Retinal fundus photograph; 2184x1690px — 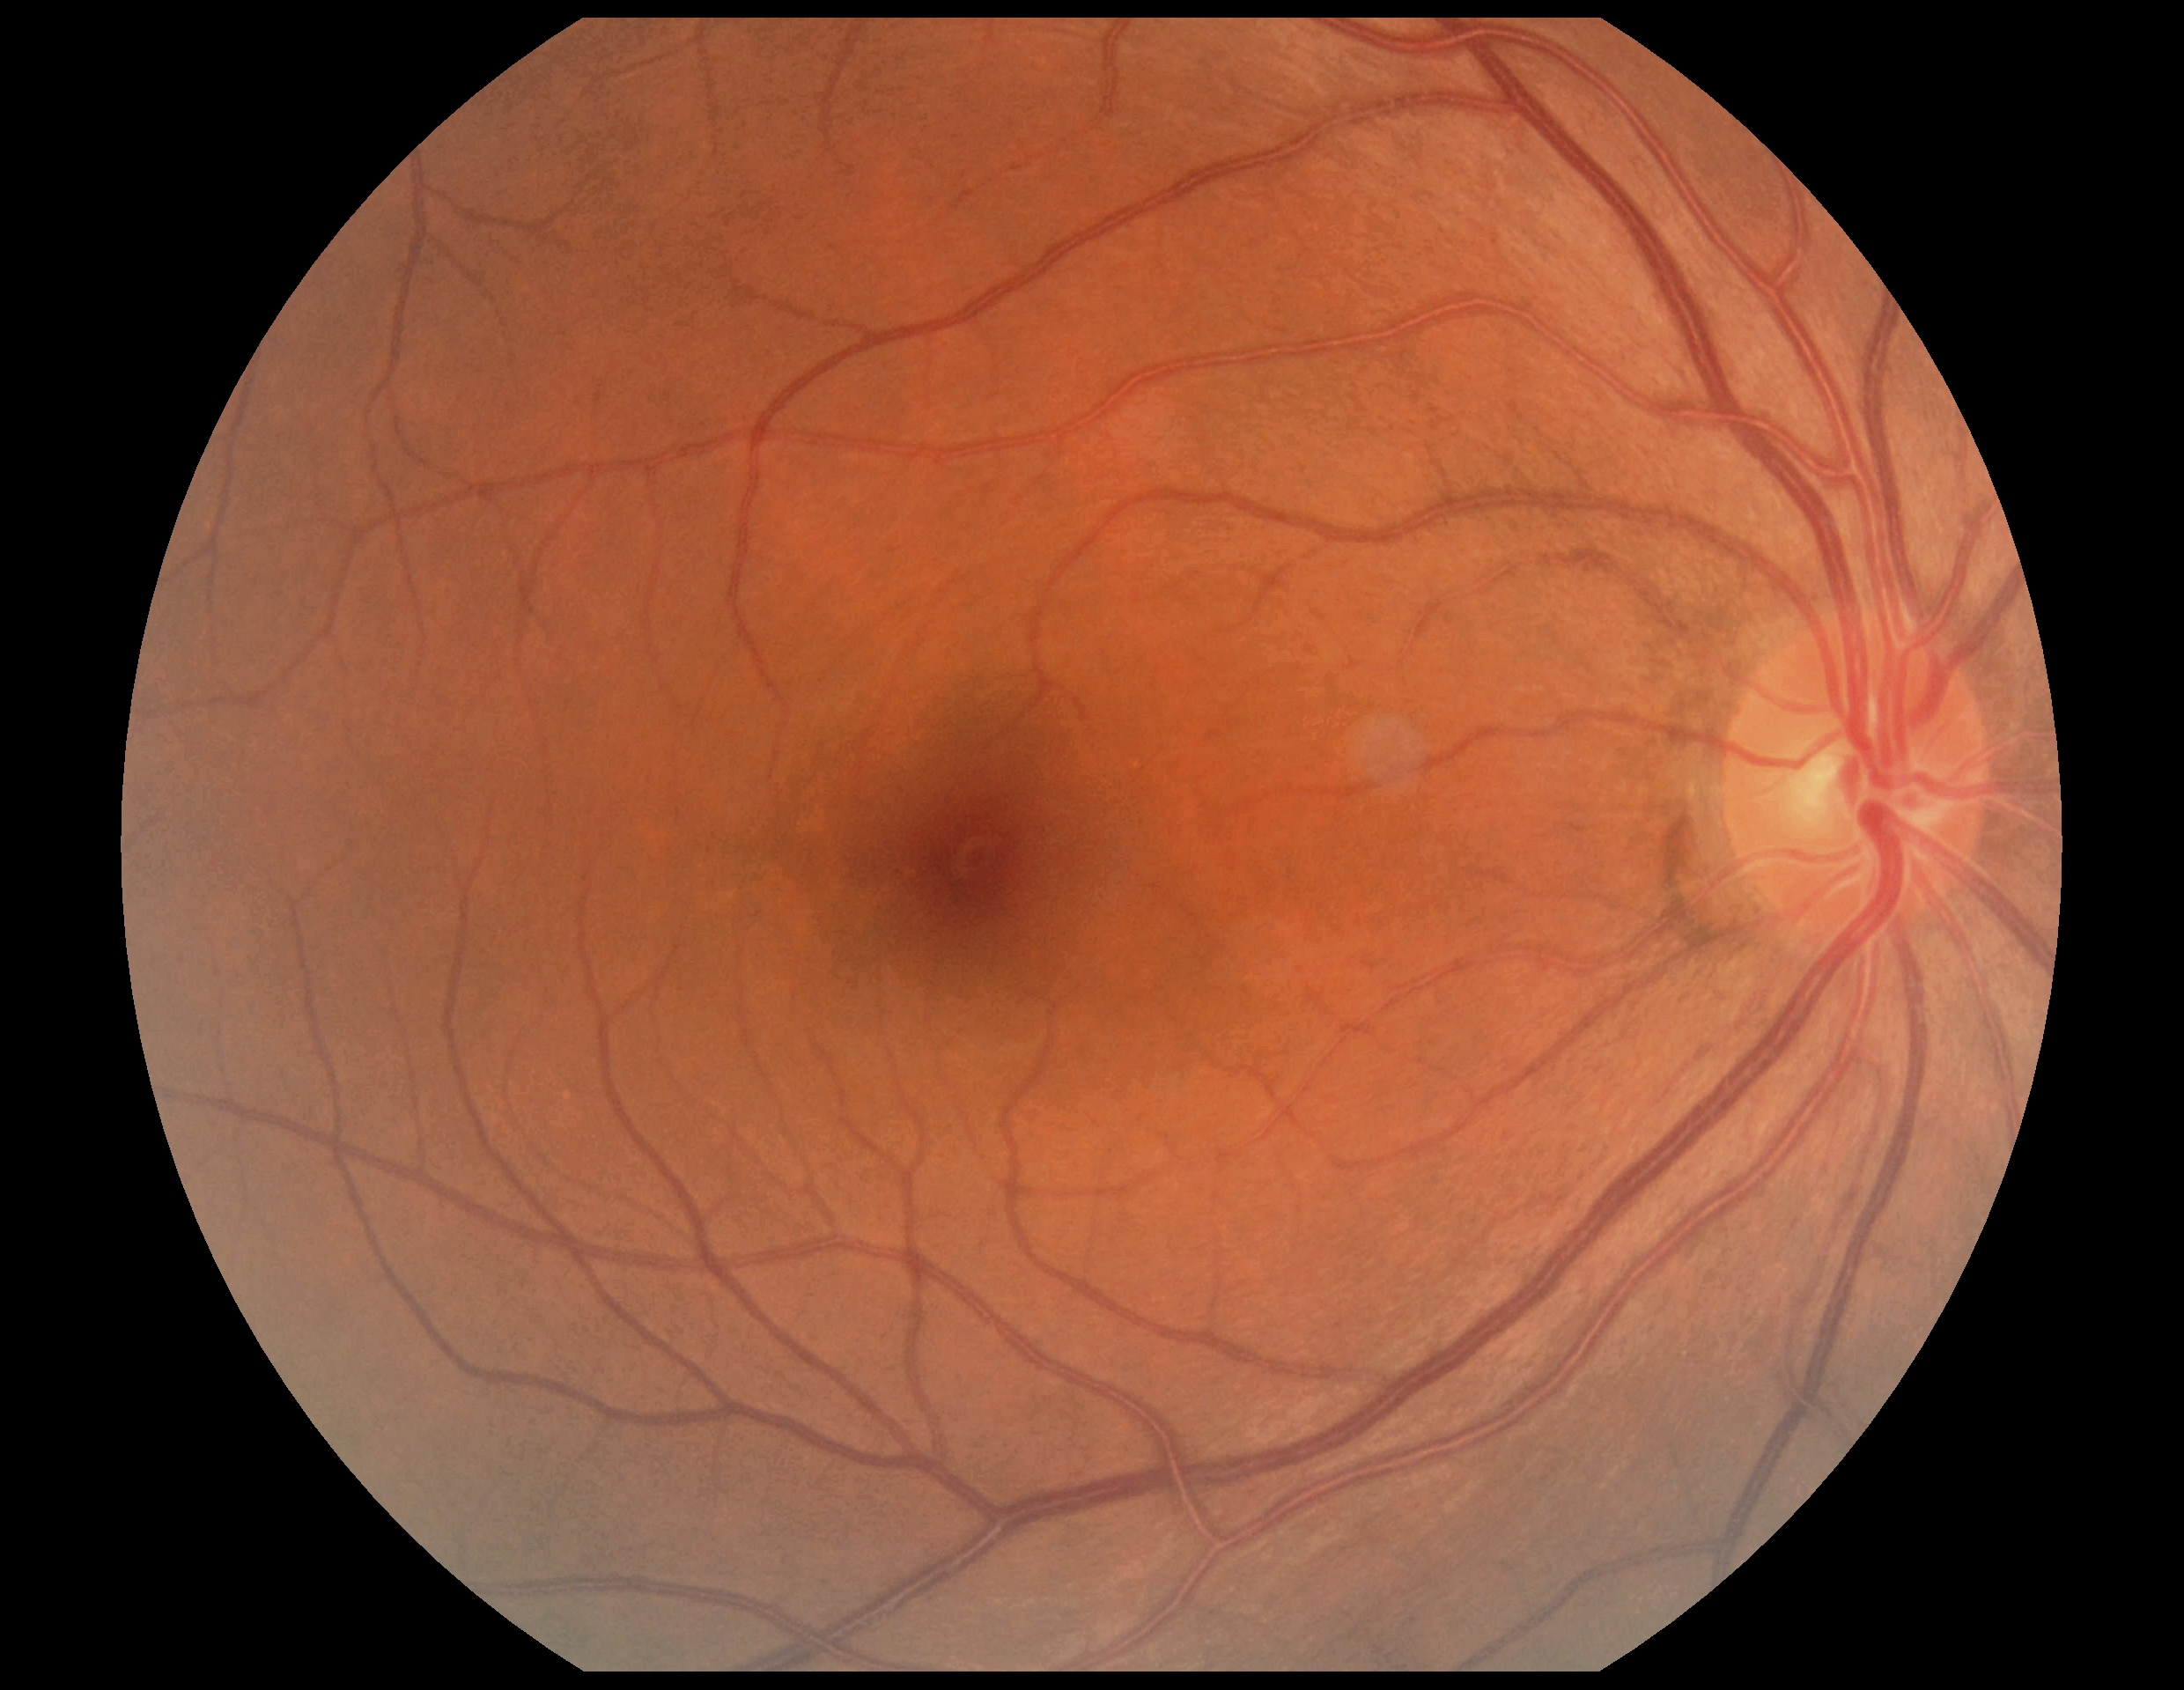 retinopathy@0, DR impression@negative for DR.